640 by 480 pixels · Clarity RetCam 3, 130° FOV · wide-field fundus photograph of an infant.
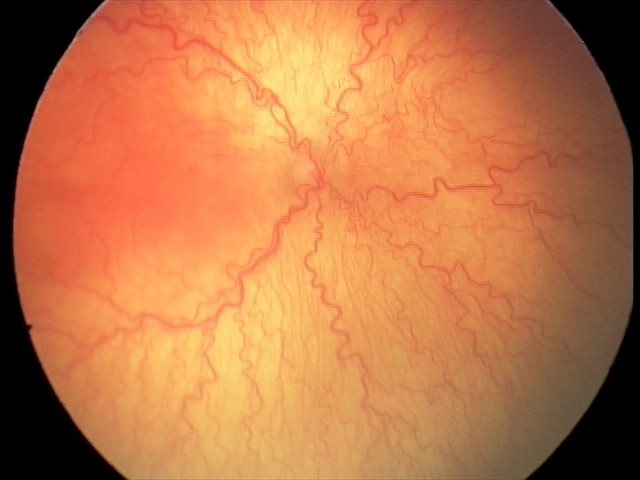

With plus disease.
From an examination with diagnosis of A-ROP (aggressive ROP).